Infant wide-field fundus photograph · image size 1440x1080 — 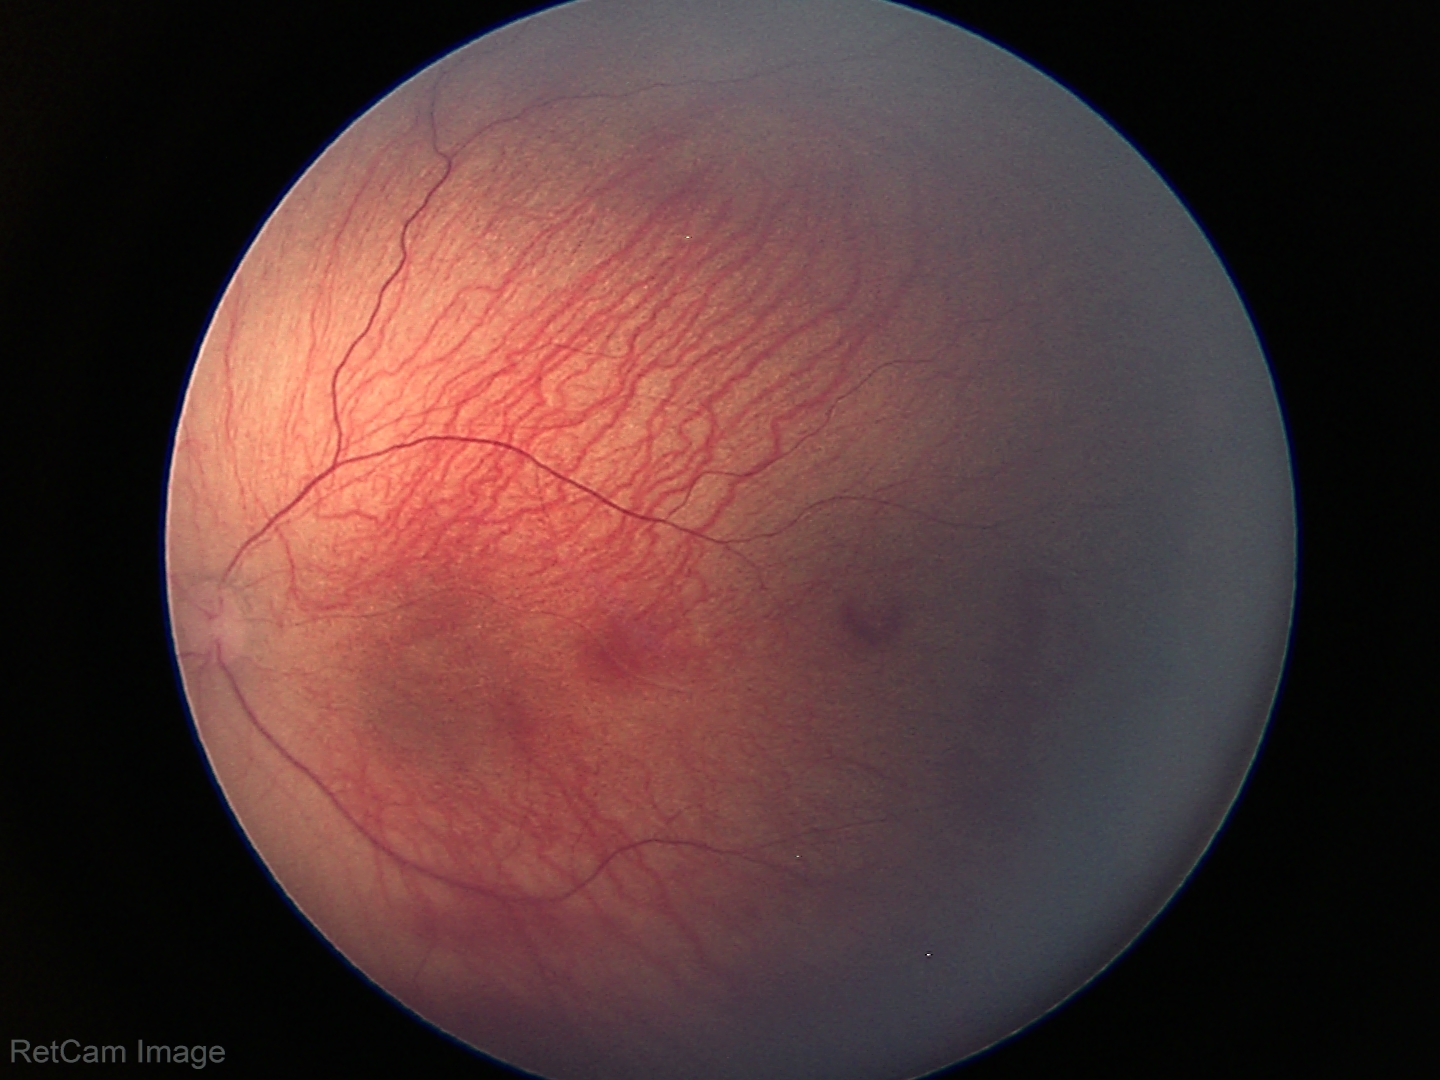 Screening: retinopathy of prematurity (ROP) stage 1 | no plus disease.